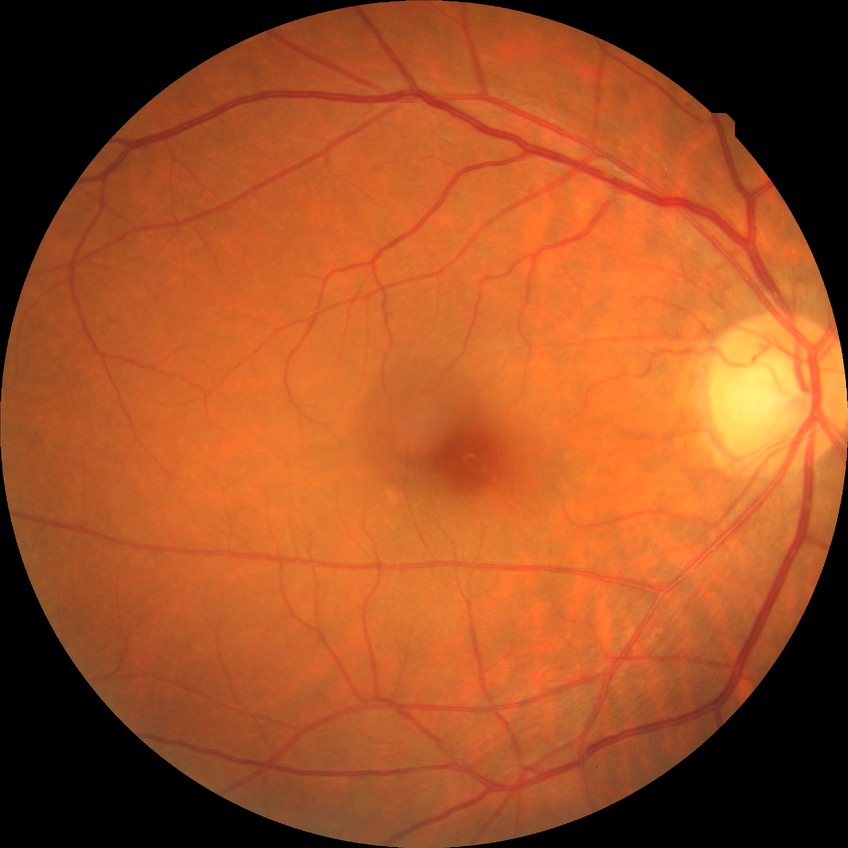
Diabetic retinopathy (DR): NDR (no diabetic retinopathy).